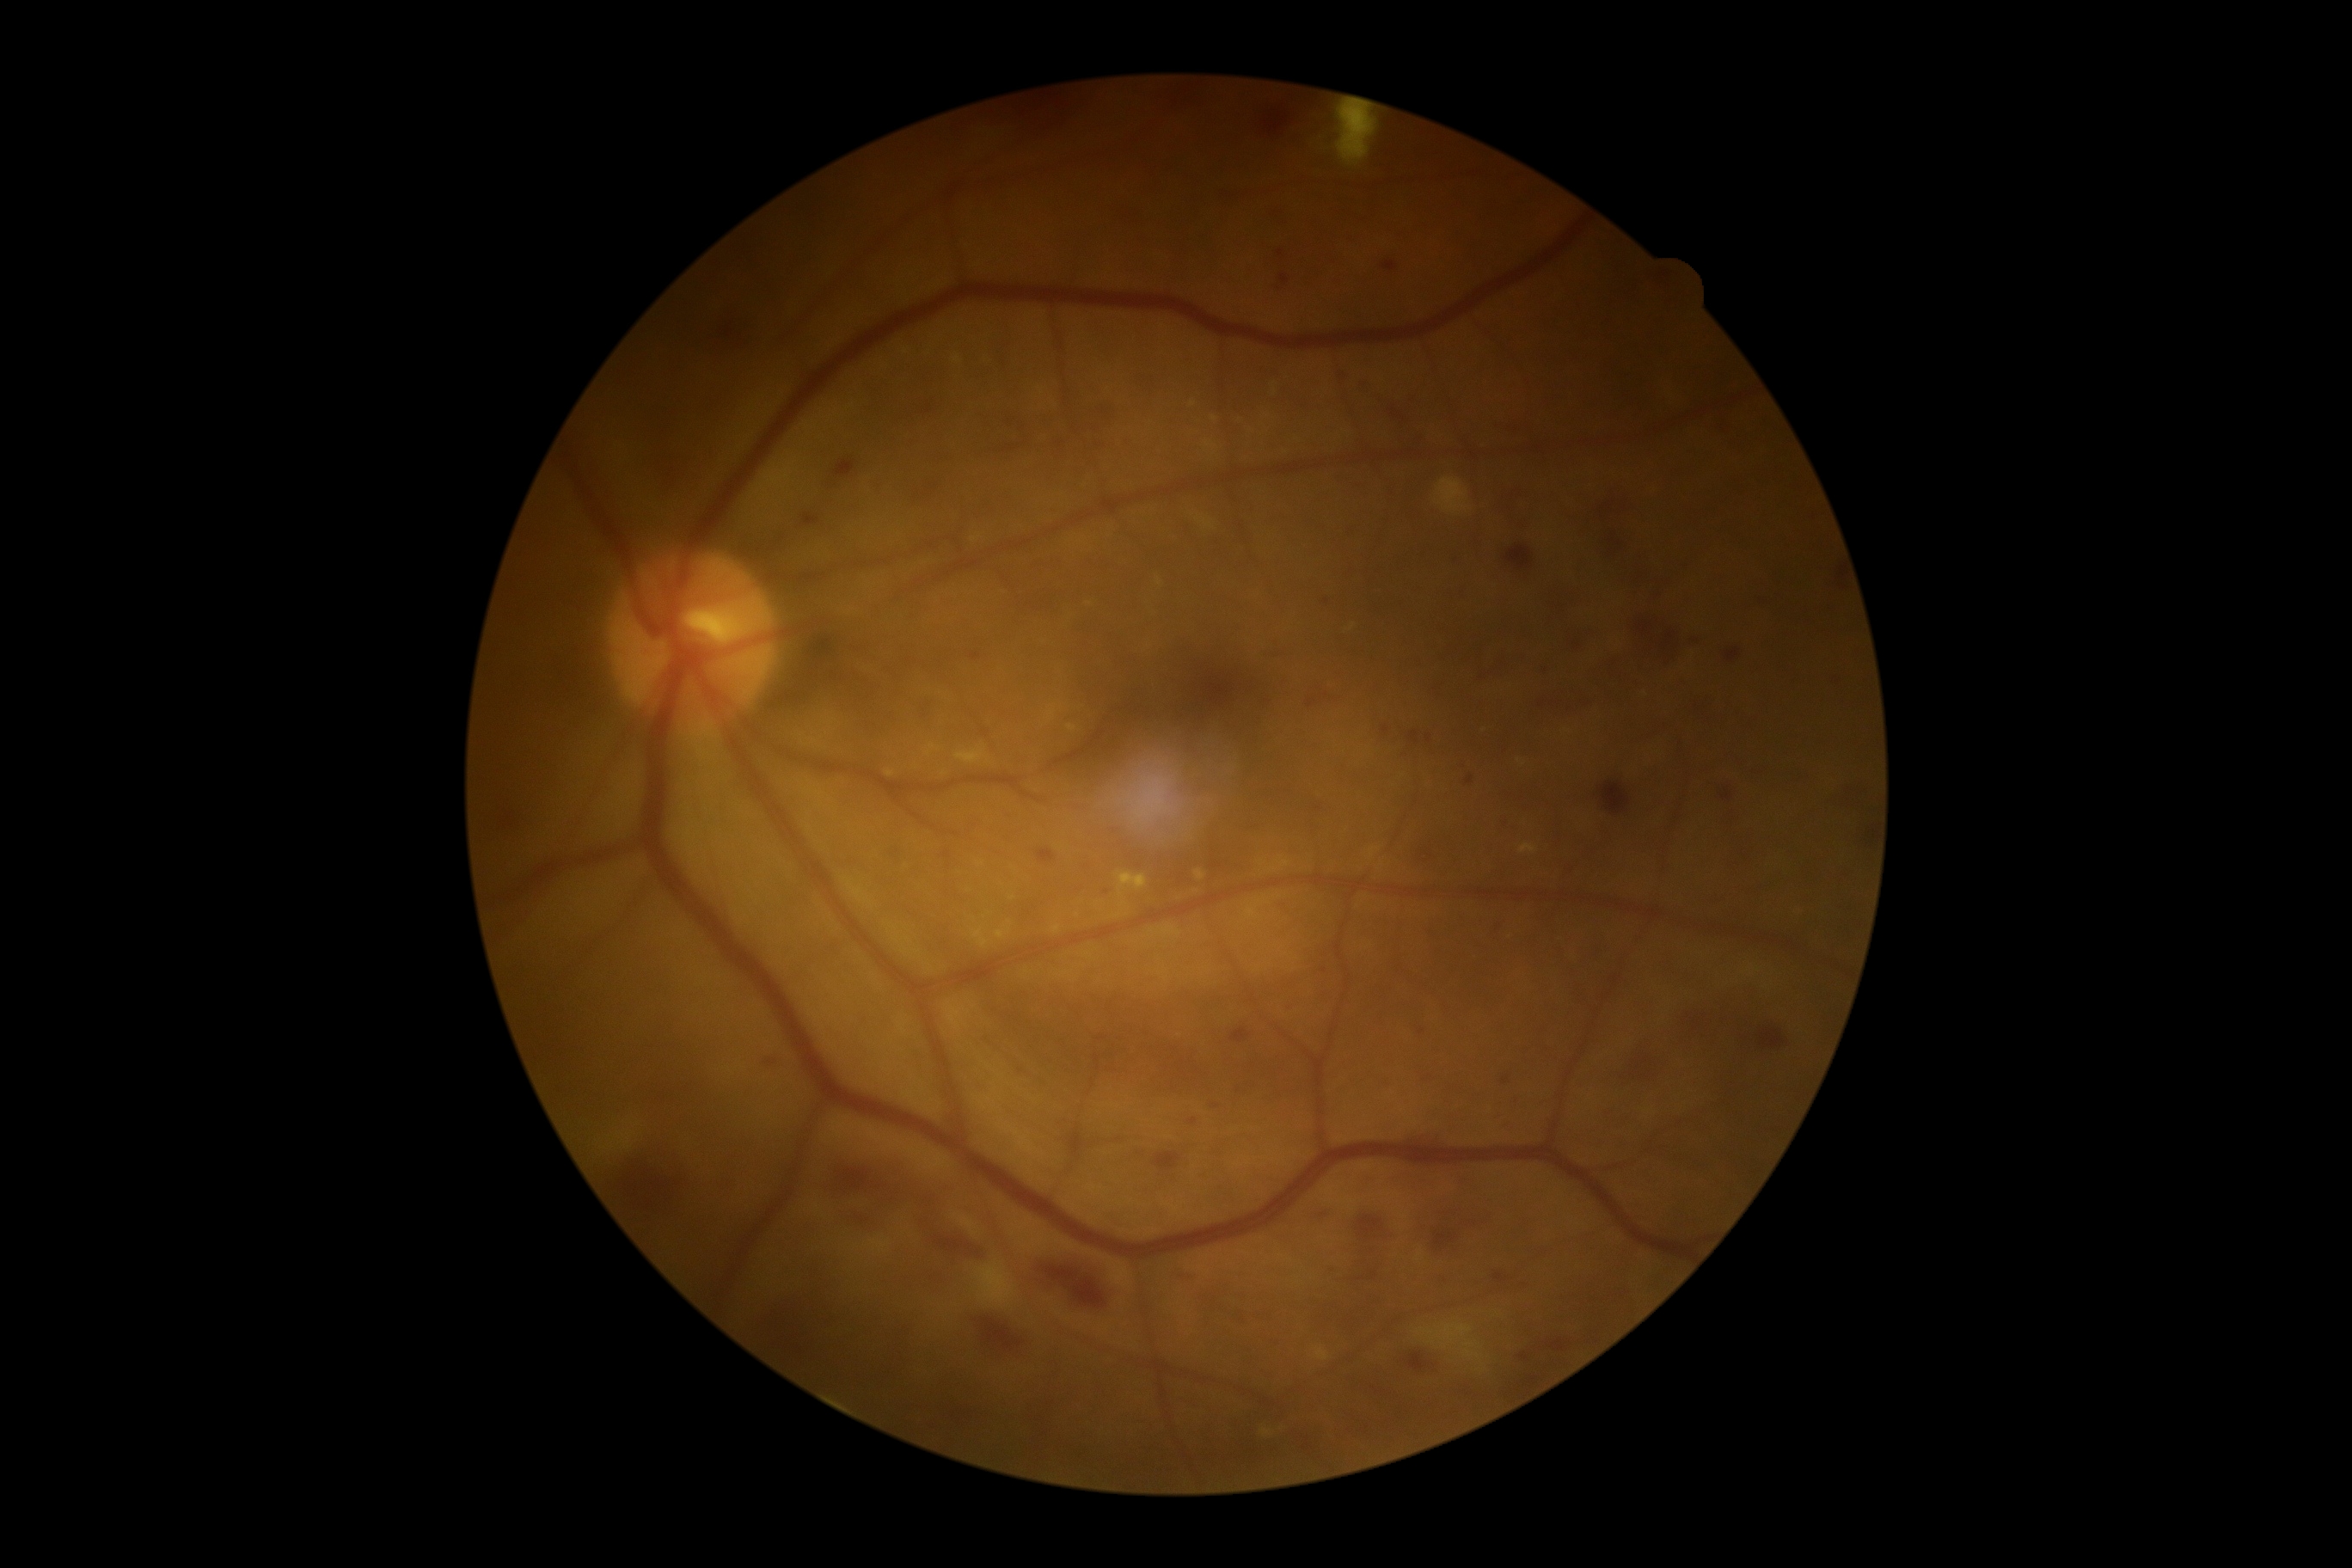

{"dr_grade": "grade 3 (severe NPDR)"}